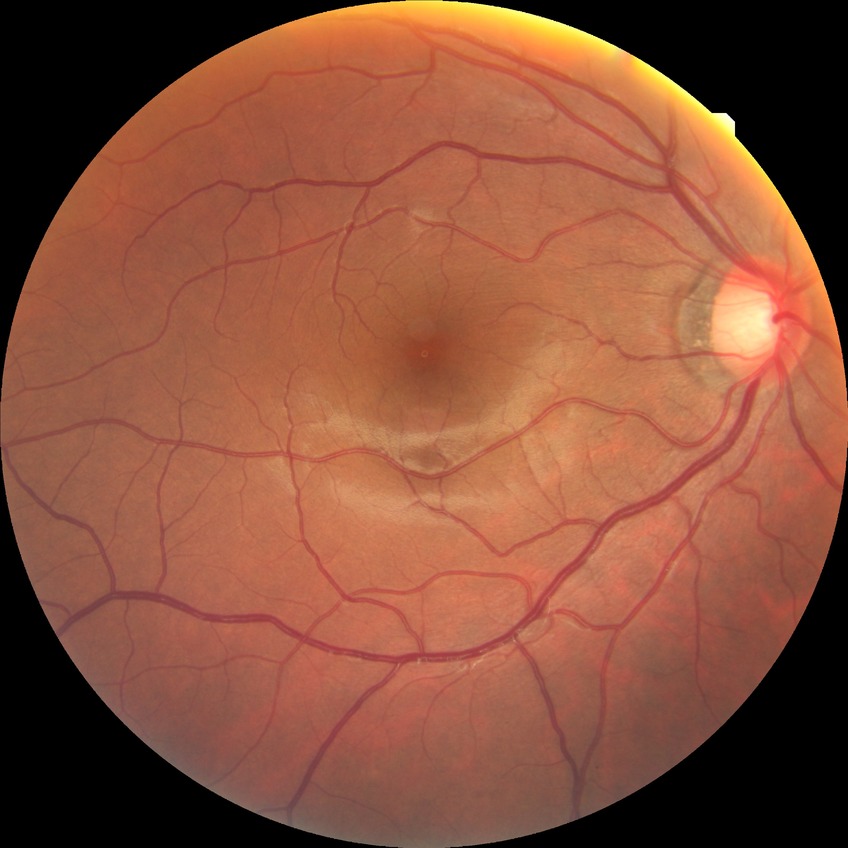
diabetic retinopathy grade: no diabetic retinopathy.